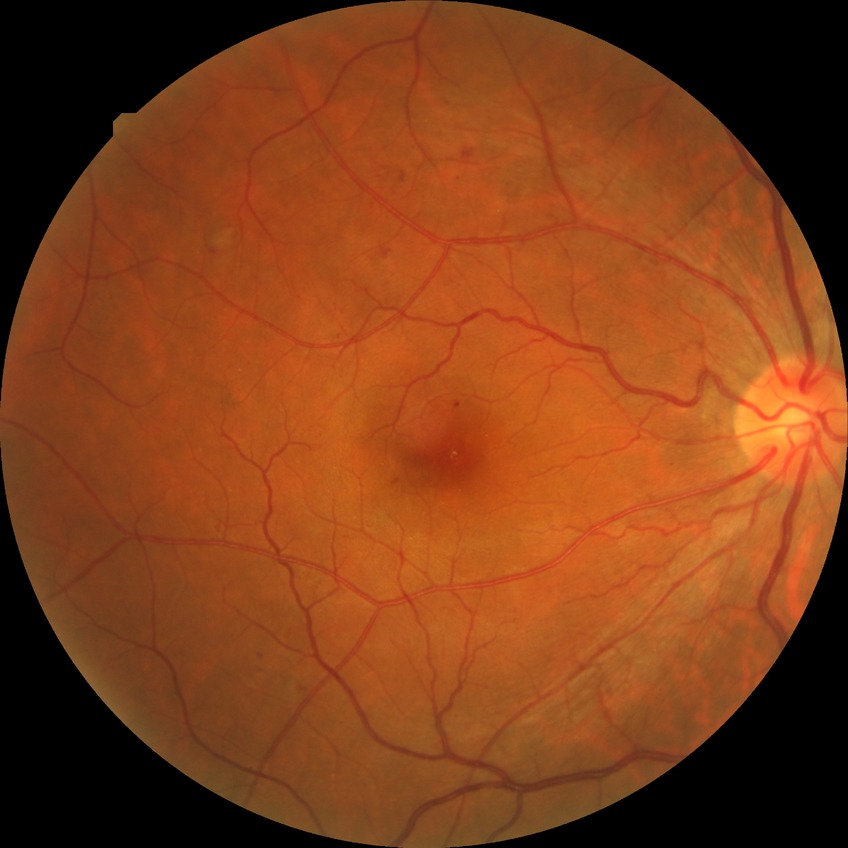
Findings:
• diabetic retinopathy grade — simple diabetic retinopathy